Diabetic retinopathy graded by the modified Davis classification — 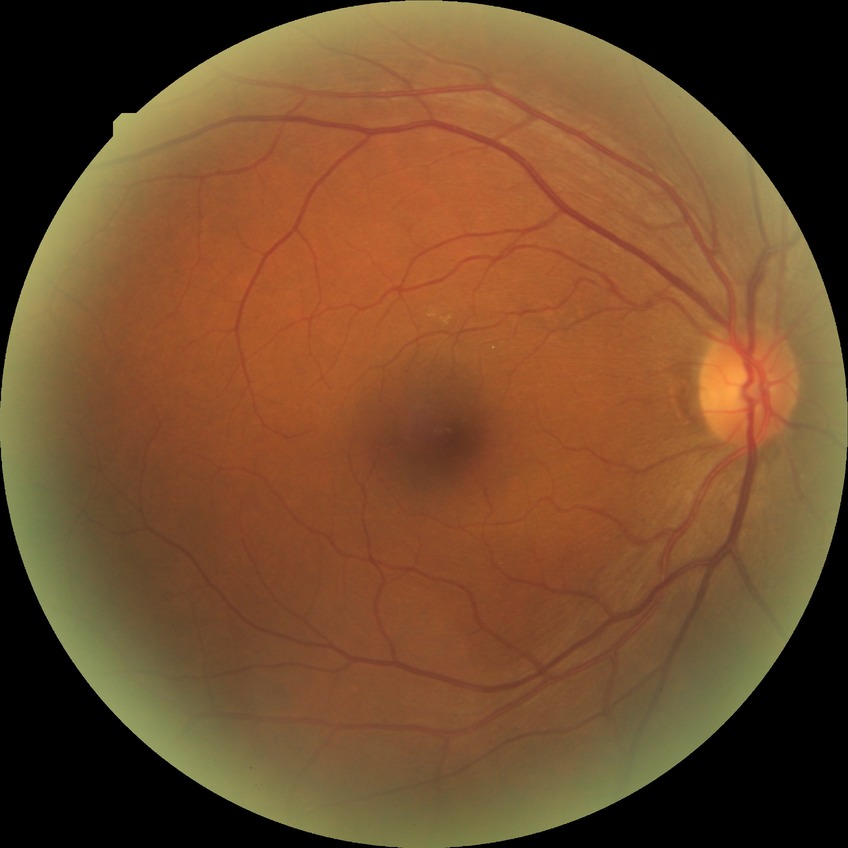

Assessment:
- retinopathy grade: no diabetic retinopathy